Fundus photo · captured without pupil dilation — 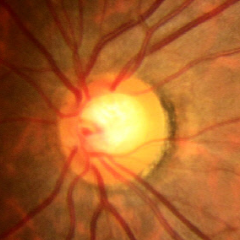
Glaucoma status = early glaucomatous changes.